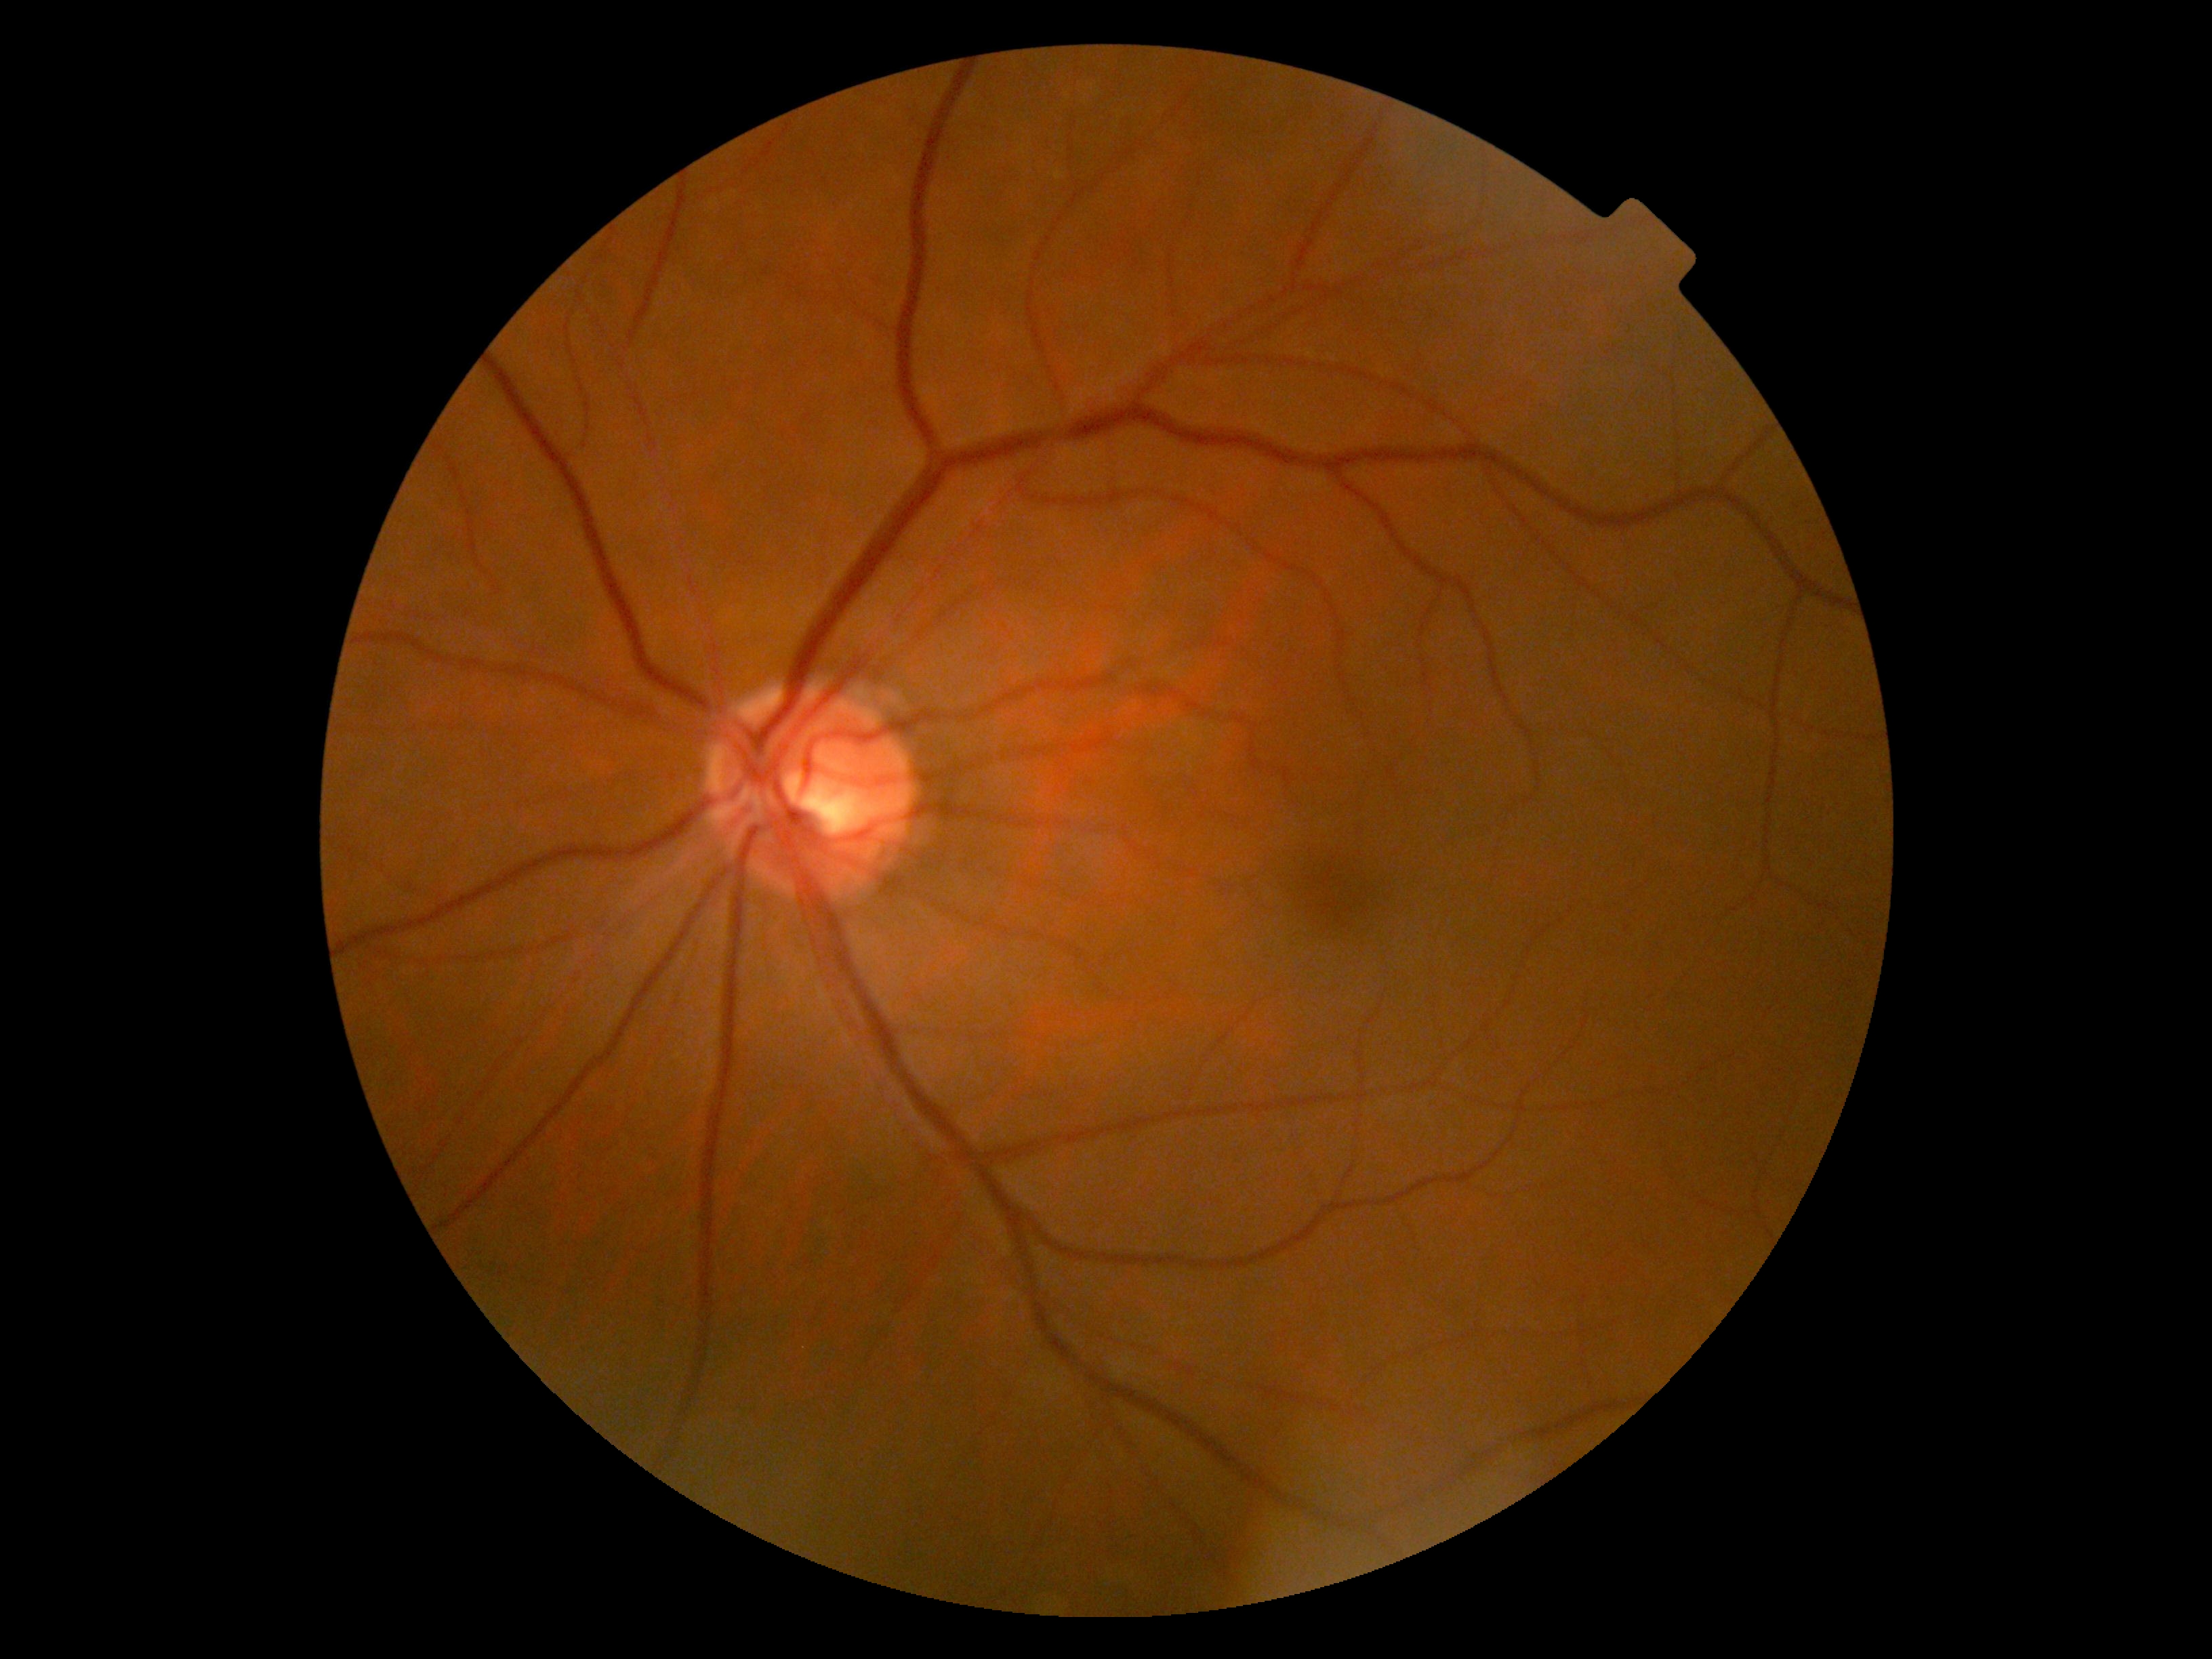

Findings:
* DR impression — negative for DR
* DR — 0